CFP, 45° FOV, 2352 x 1568 pixels: 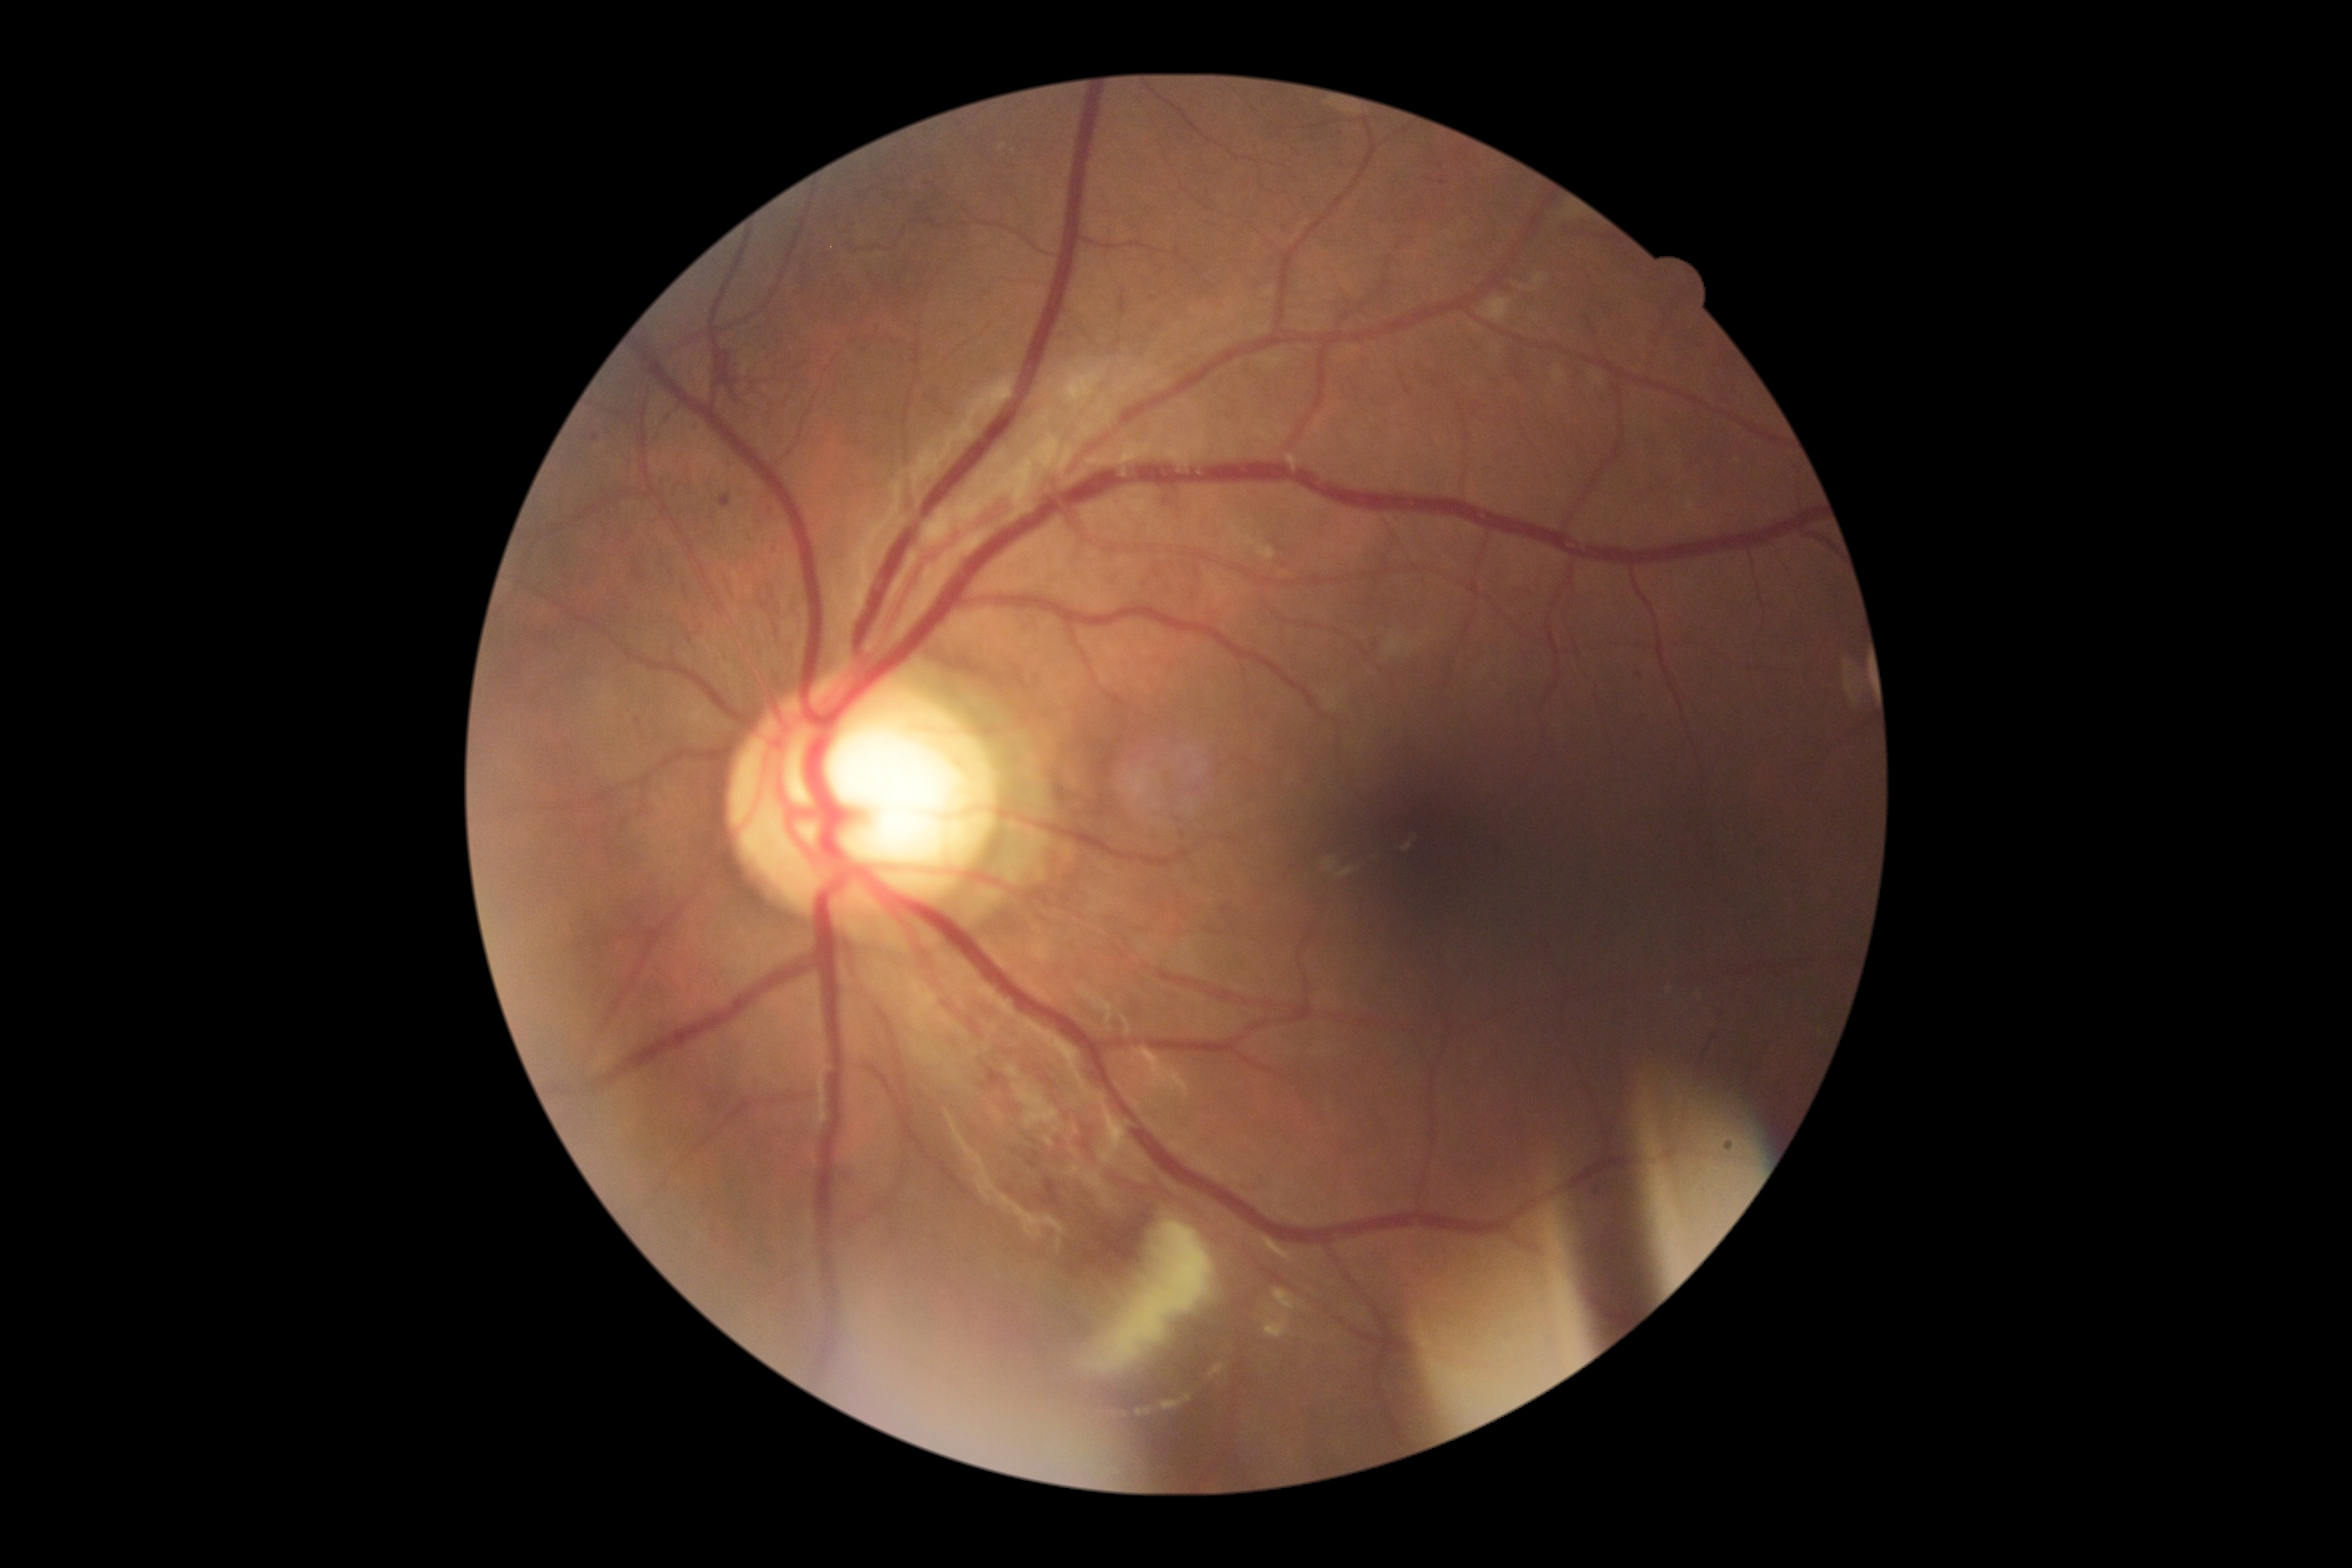
retinopathy grade: 3 (severe NPDR) — more than 20 intraretinal hemorrhages in each of 4 quadrants, definite venous beading in 2 or more quadrants, or prominent intraretinal microvascular abnormalities in 1 or more quadrants, with no signs of proliferative retinopathy.